640 x 480 pixels; infant wide-field fundus photograph
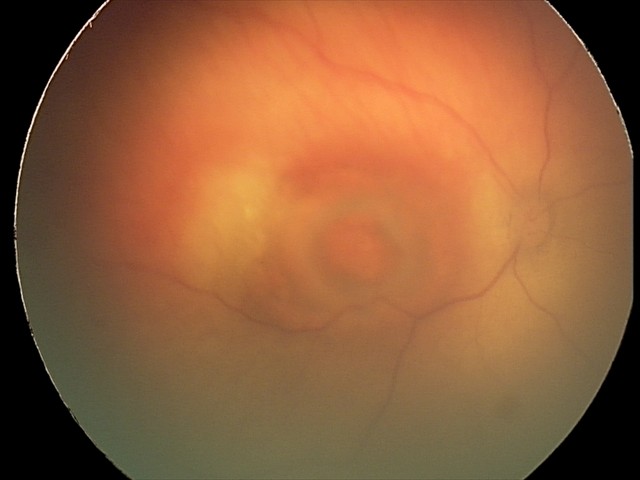
Series diagnosed as toxoplasmosis chorioretinitis.